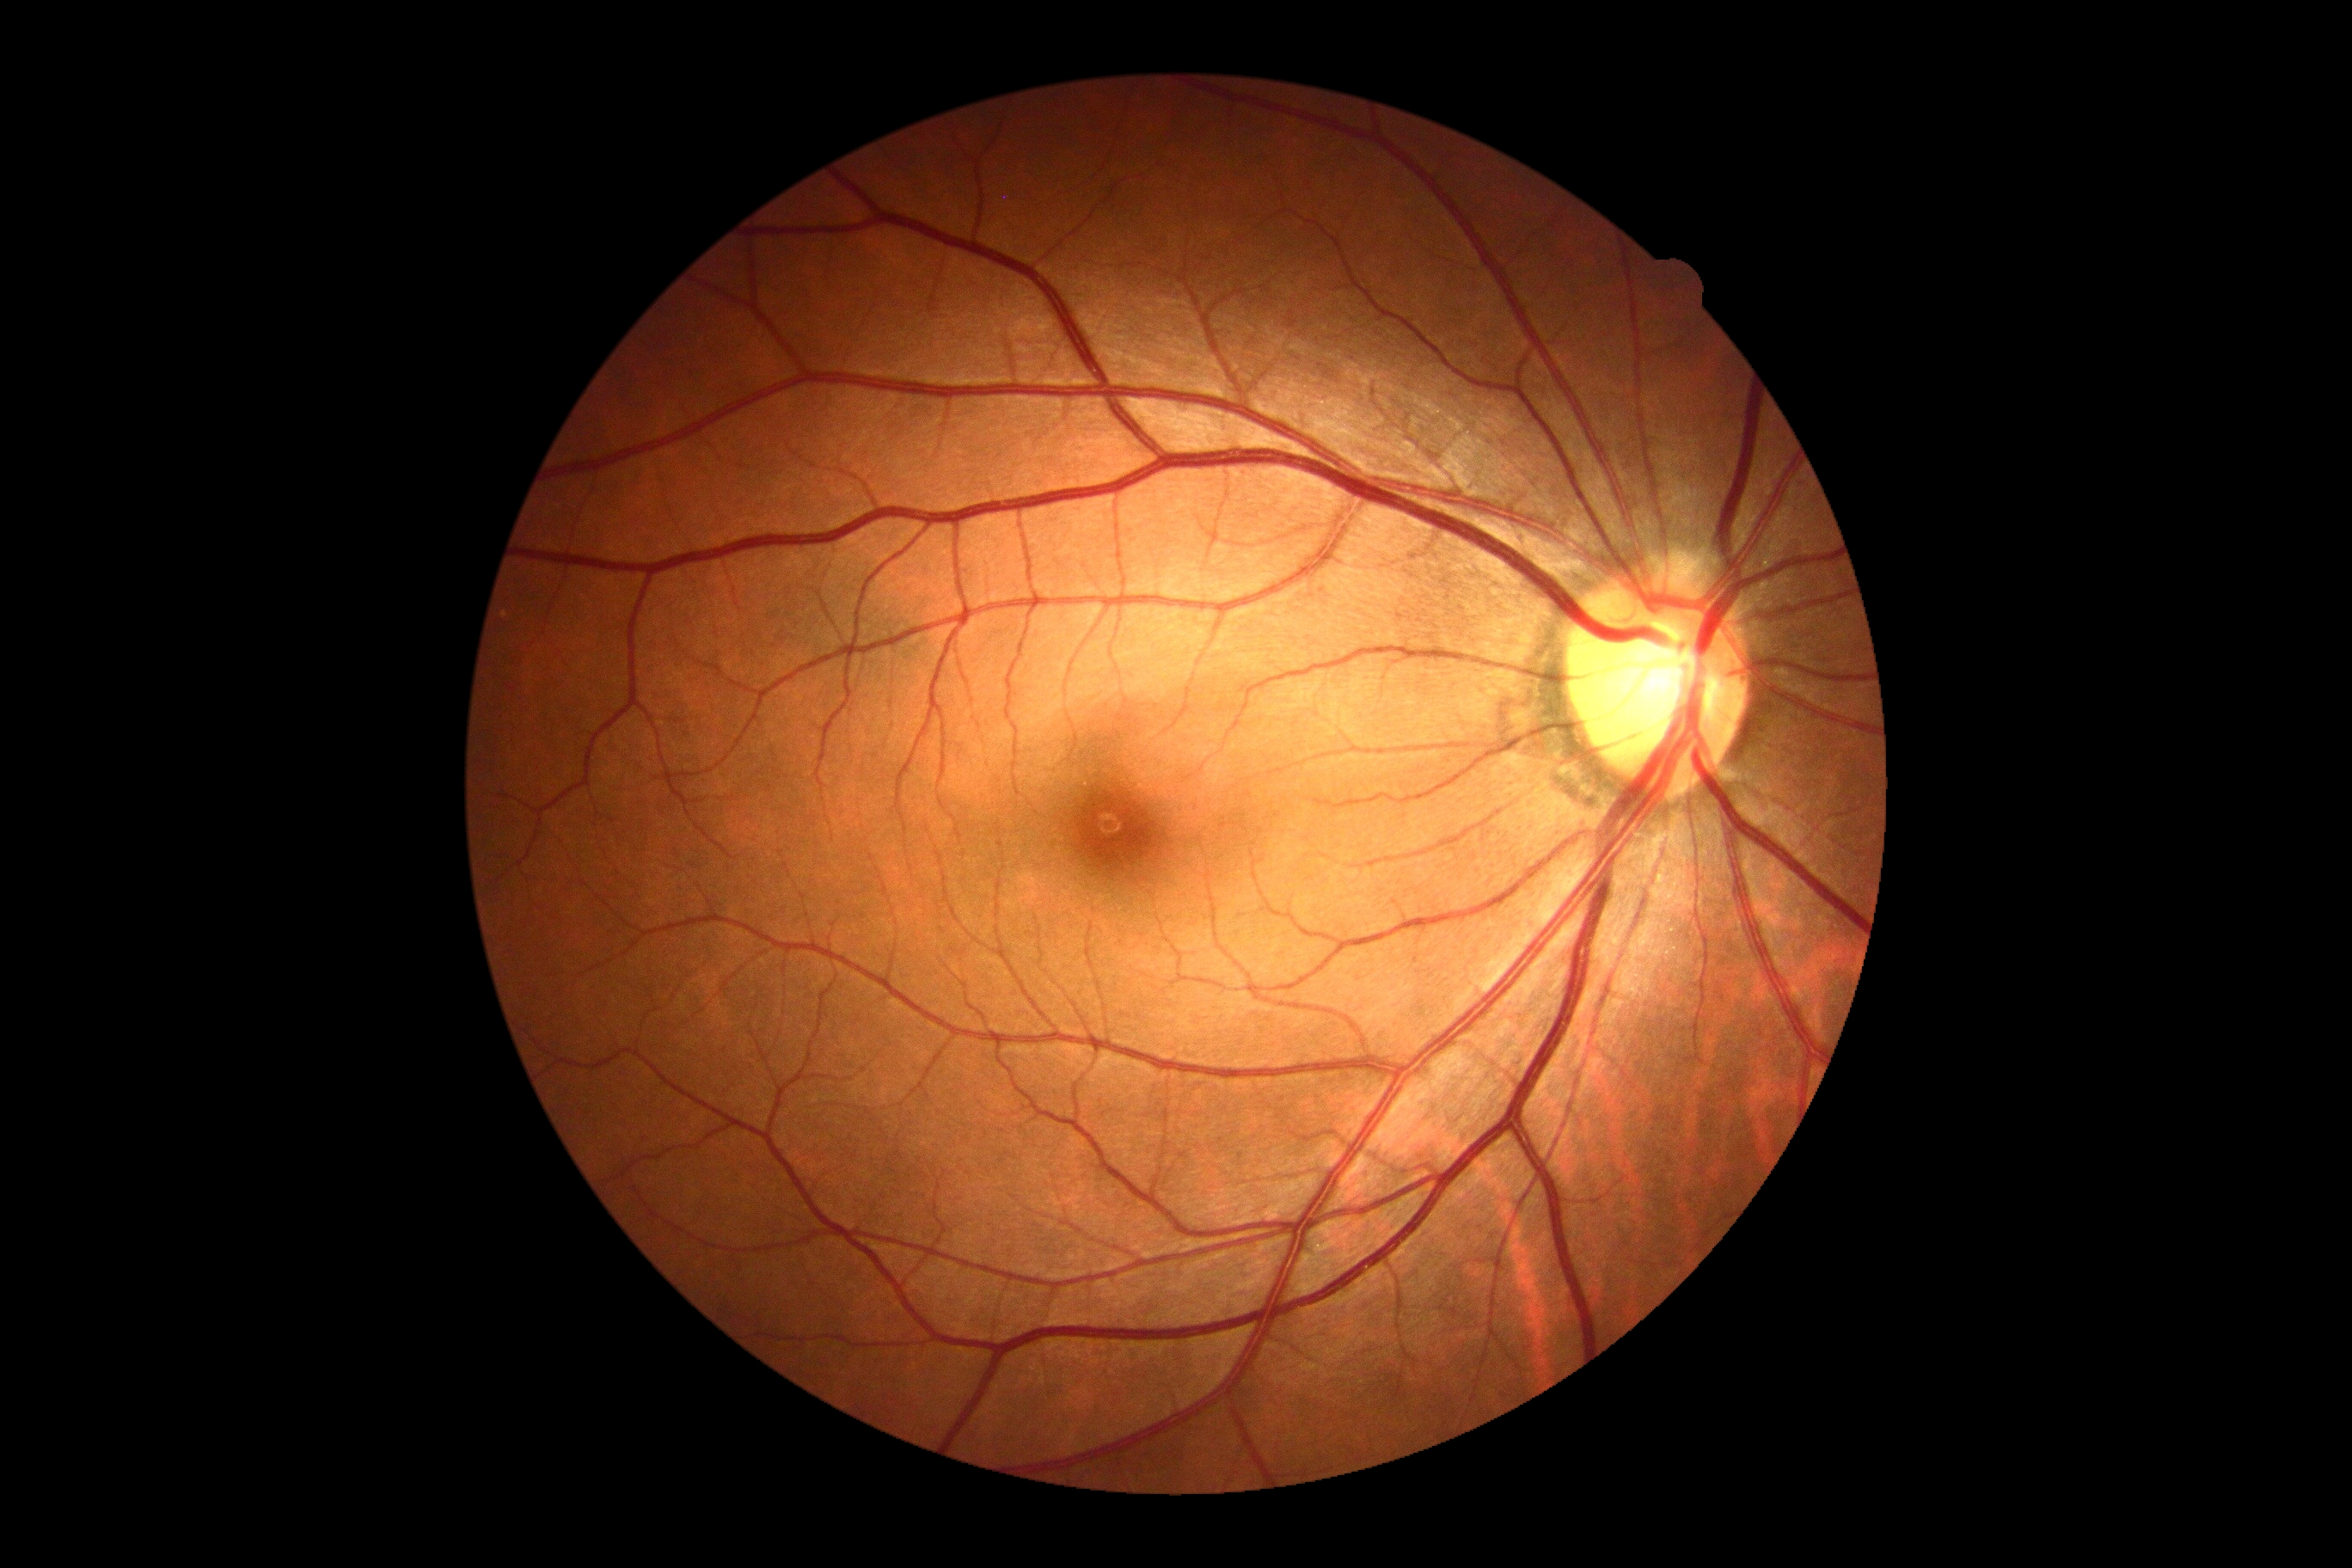

DR severity: 0; DR impression: no apparent DR.